Camera: NIDEK AFC-230 — 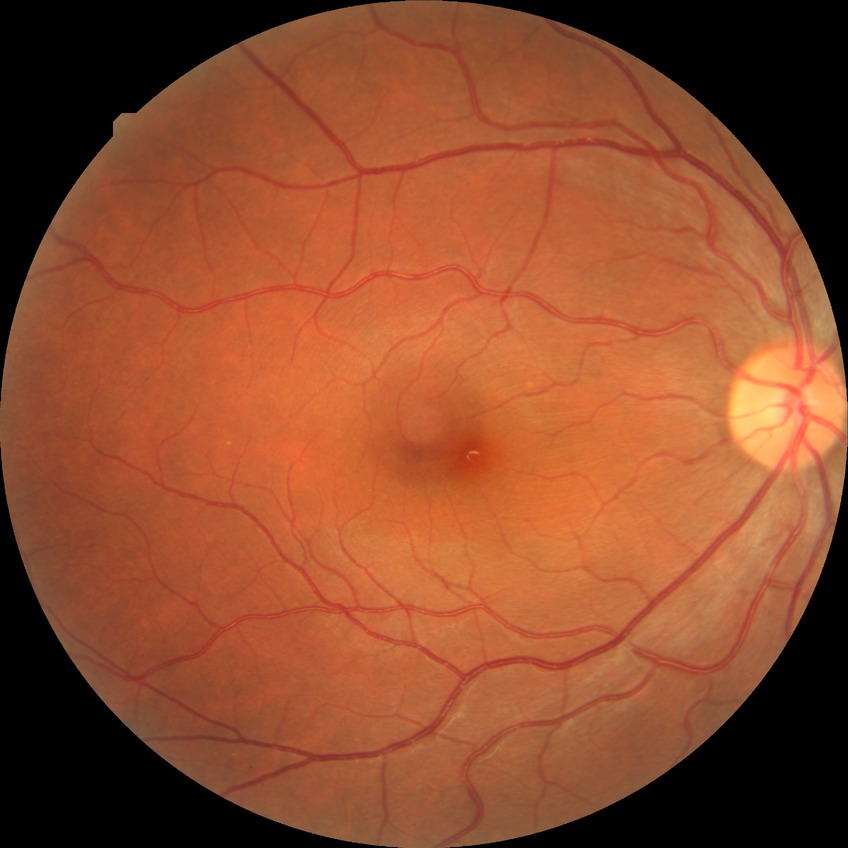

Modified Davis grading is no diabetic retinopathy.